Acquired with a NIDEK AFC-230 — 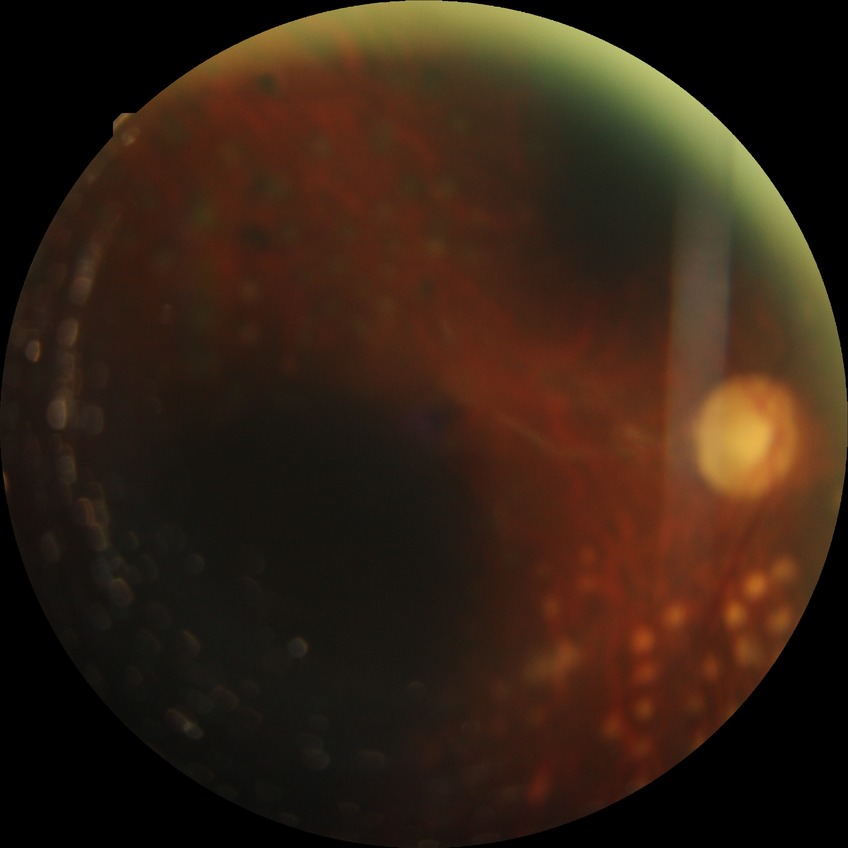 diabetic retinopathy (DR)=proliferative diabetic retinopathy (PDR).